Captured with the Phoenix ICON (100° field of view) · pediatric retinal photograph (wide-field) — 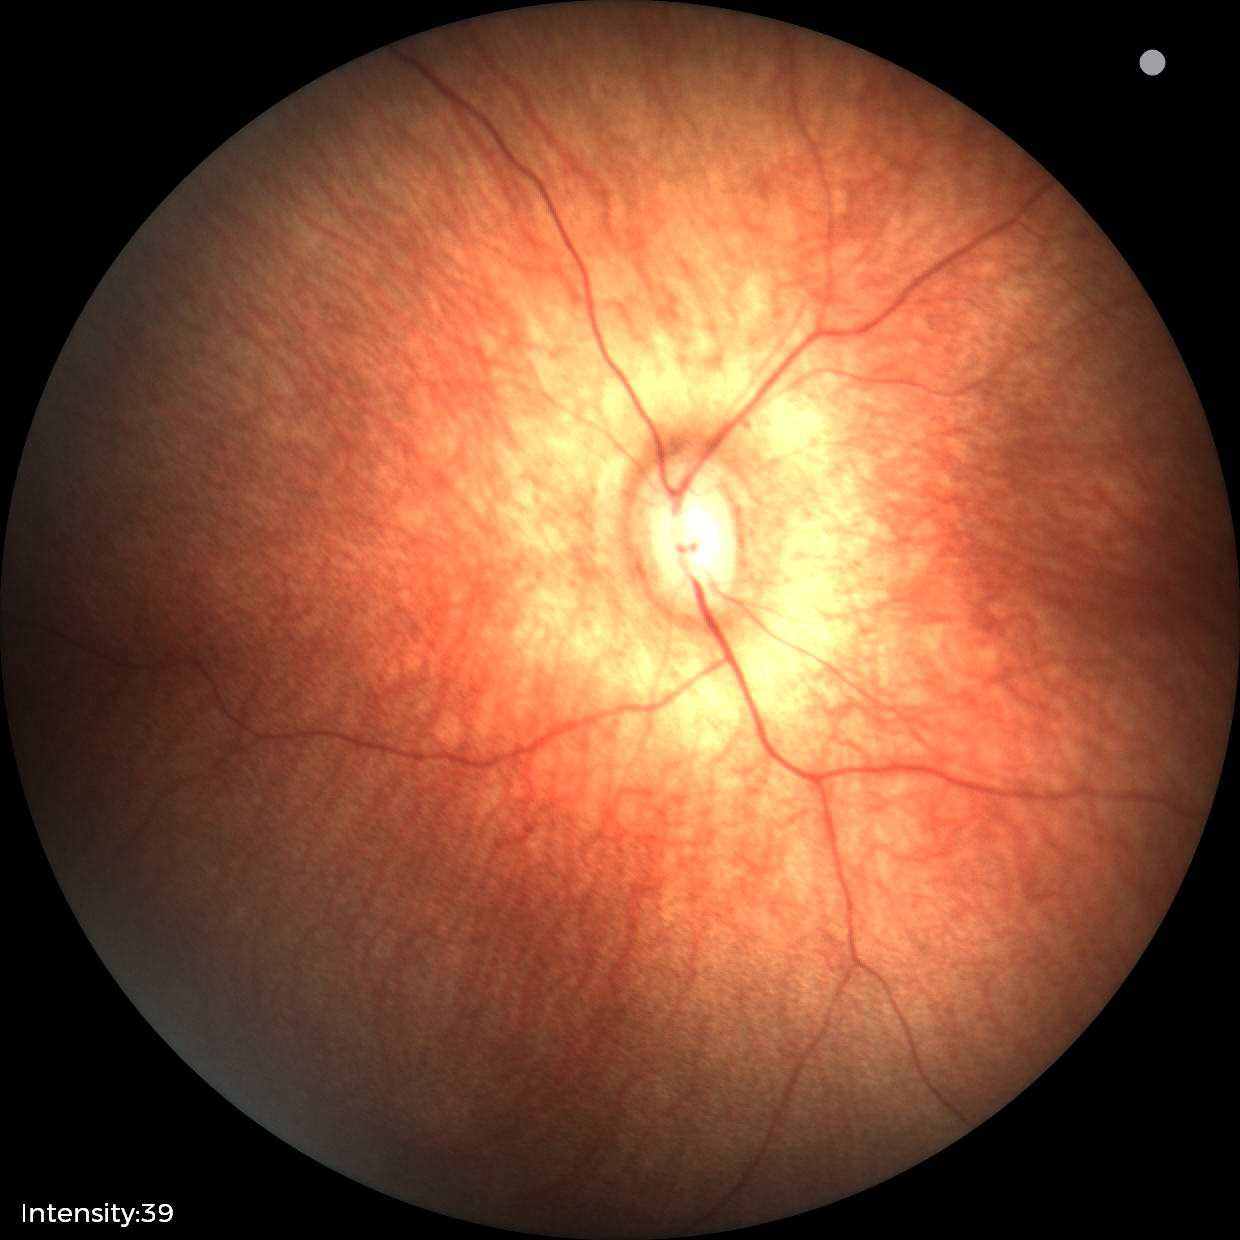
Impression: no abnormal retinal findings.